Wide-field fundus photograph from neonatal ROP screening. Camera: Clarity RetCam 3 (130° FOV):
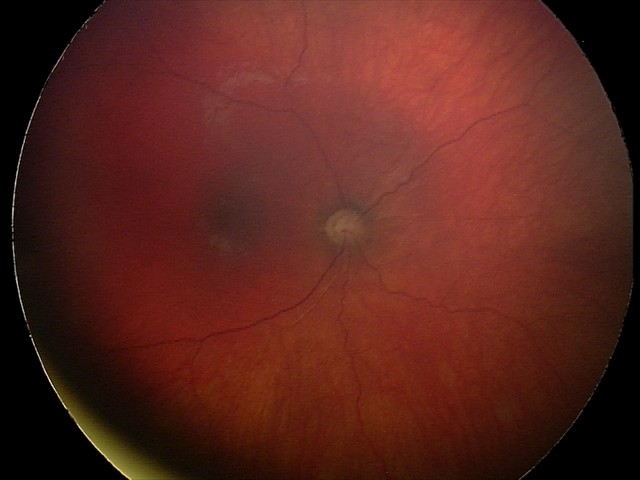 From an examination with diagnosis of optic nerve hypoplasia.